Fundus photo, 45-degree field of view
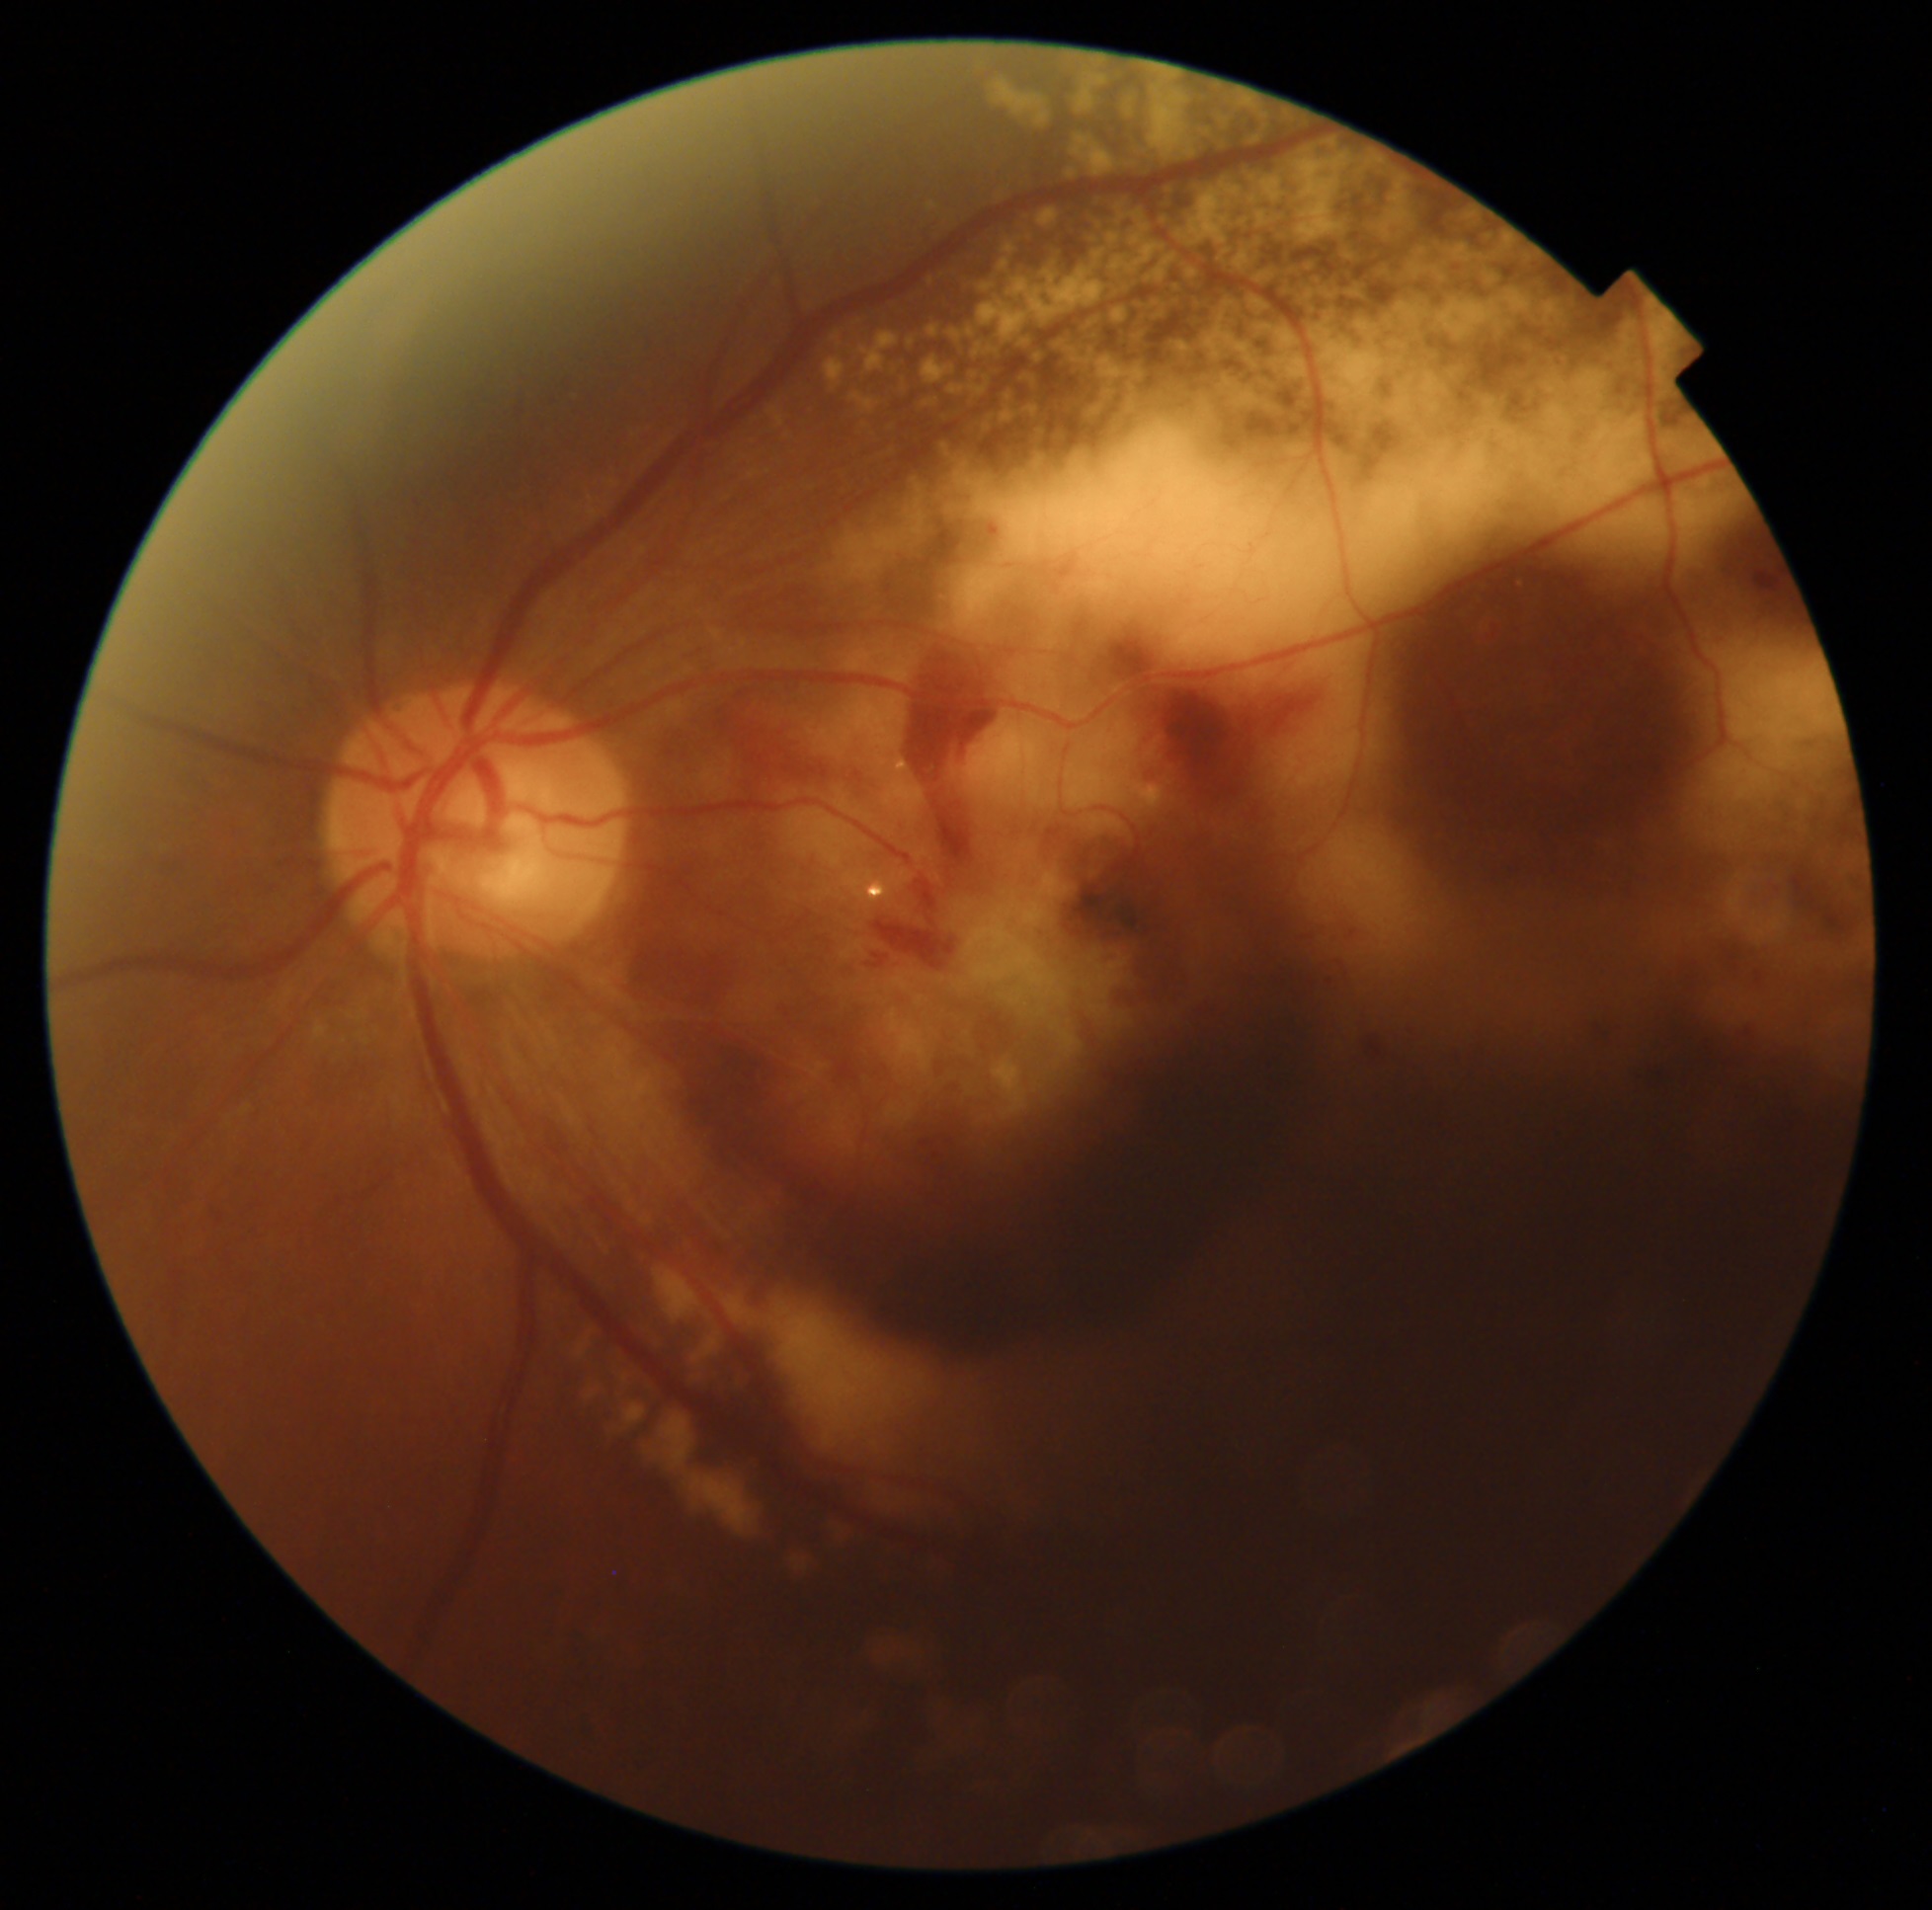

DR grade is 4/4.